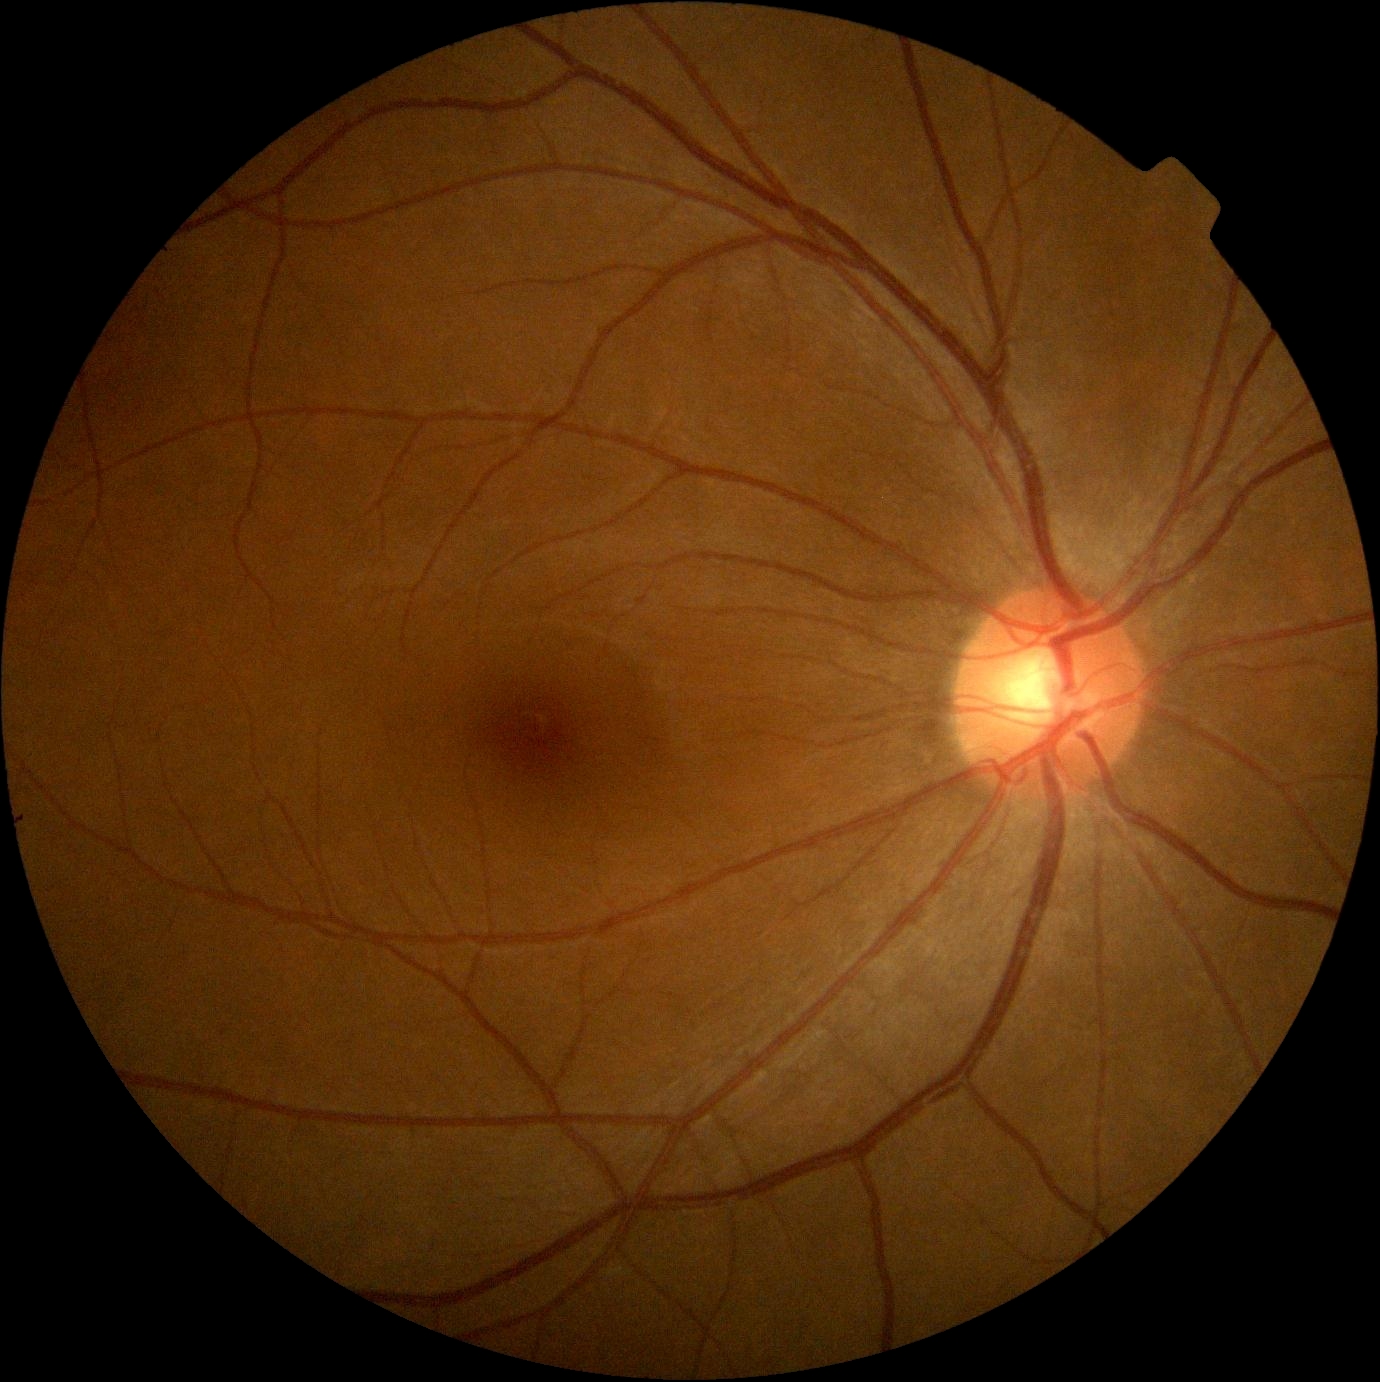
* retinopathy: grade 0